2352x1568
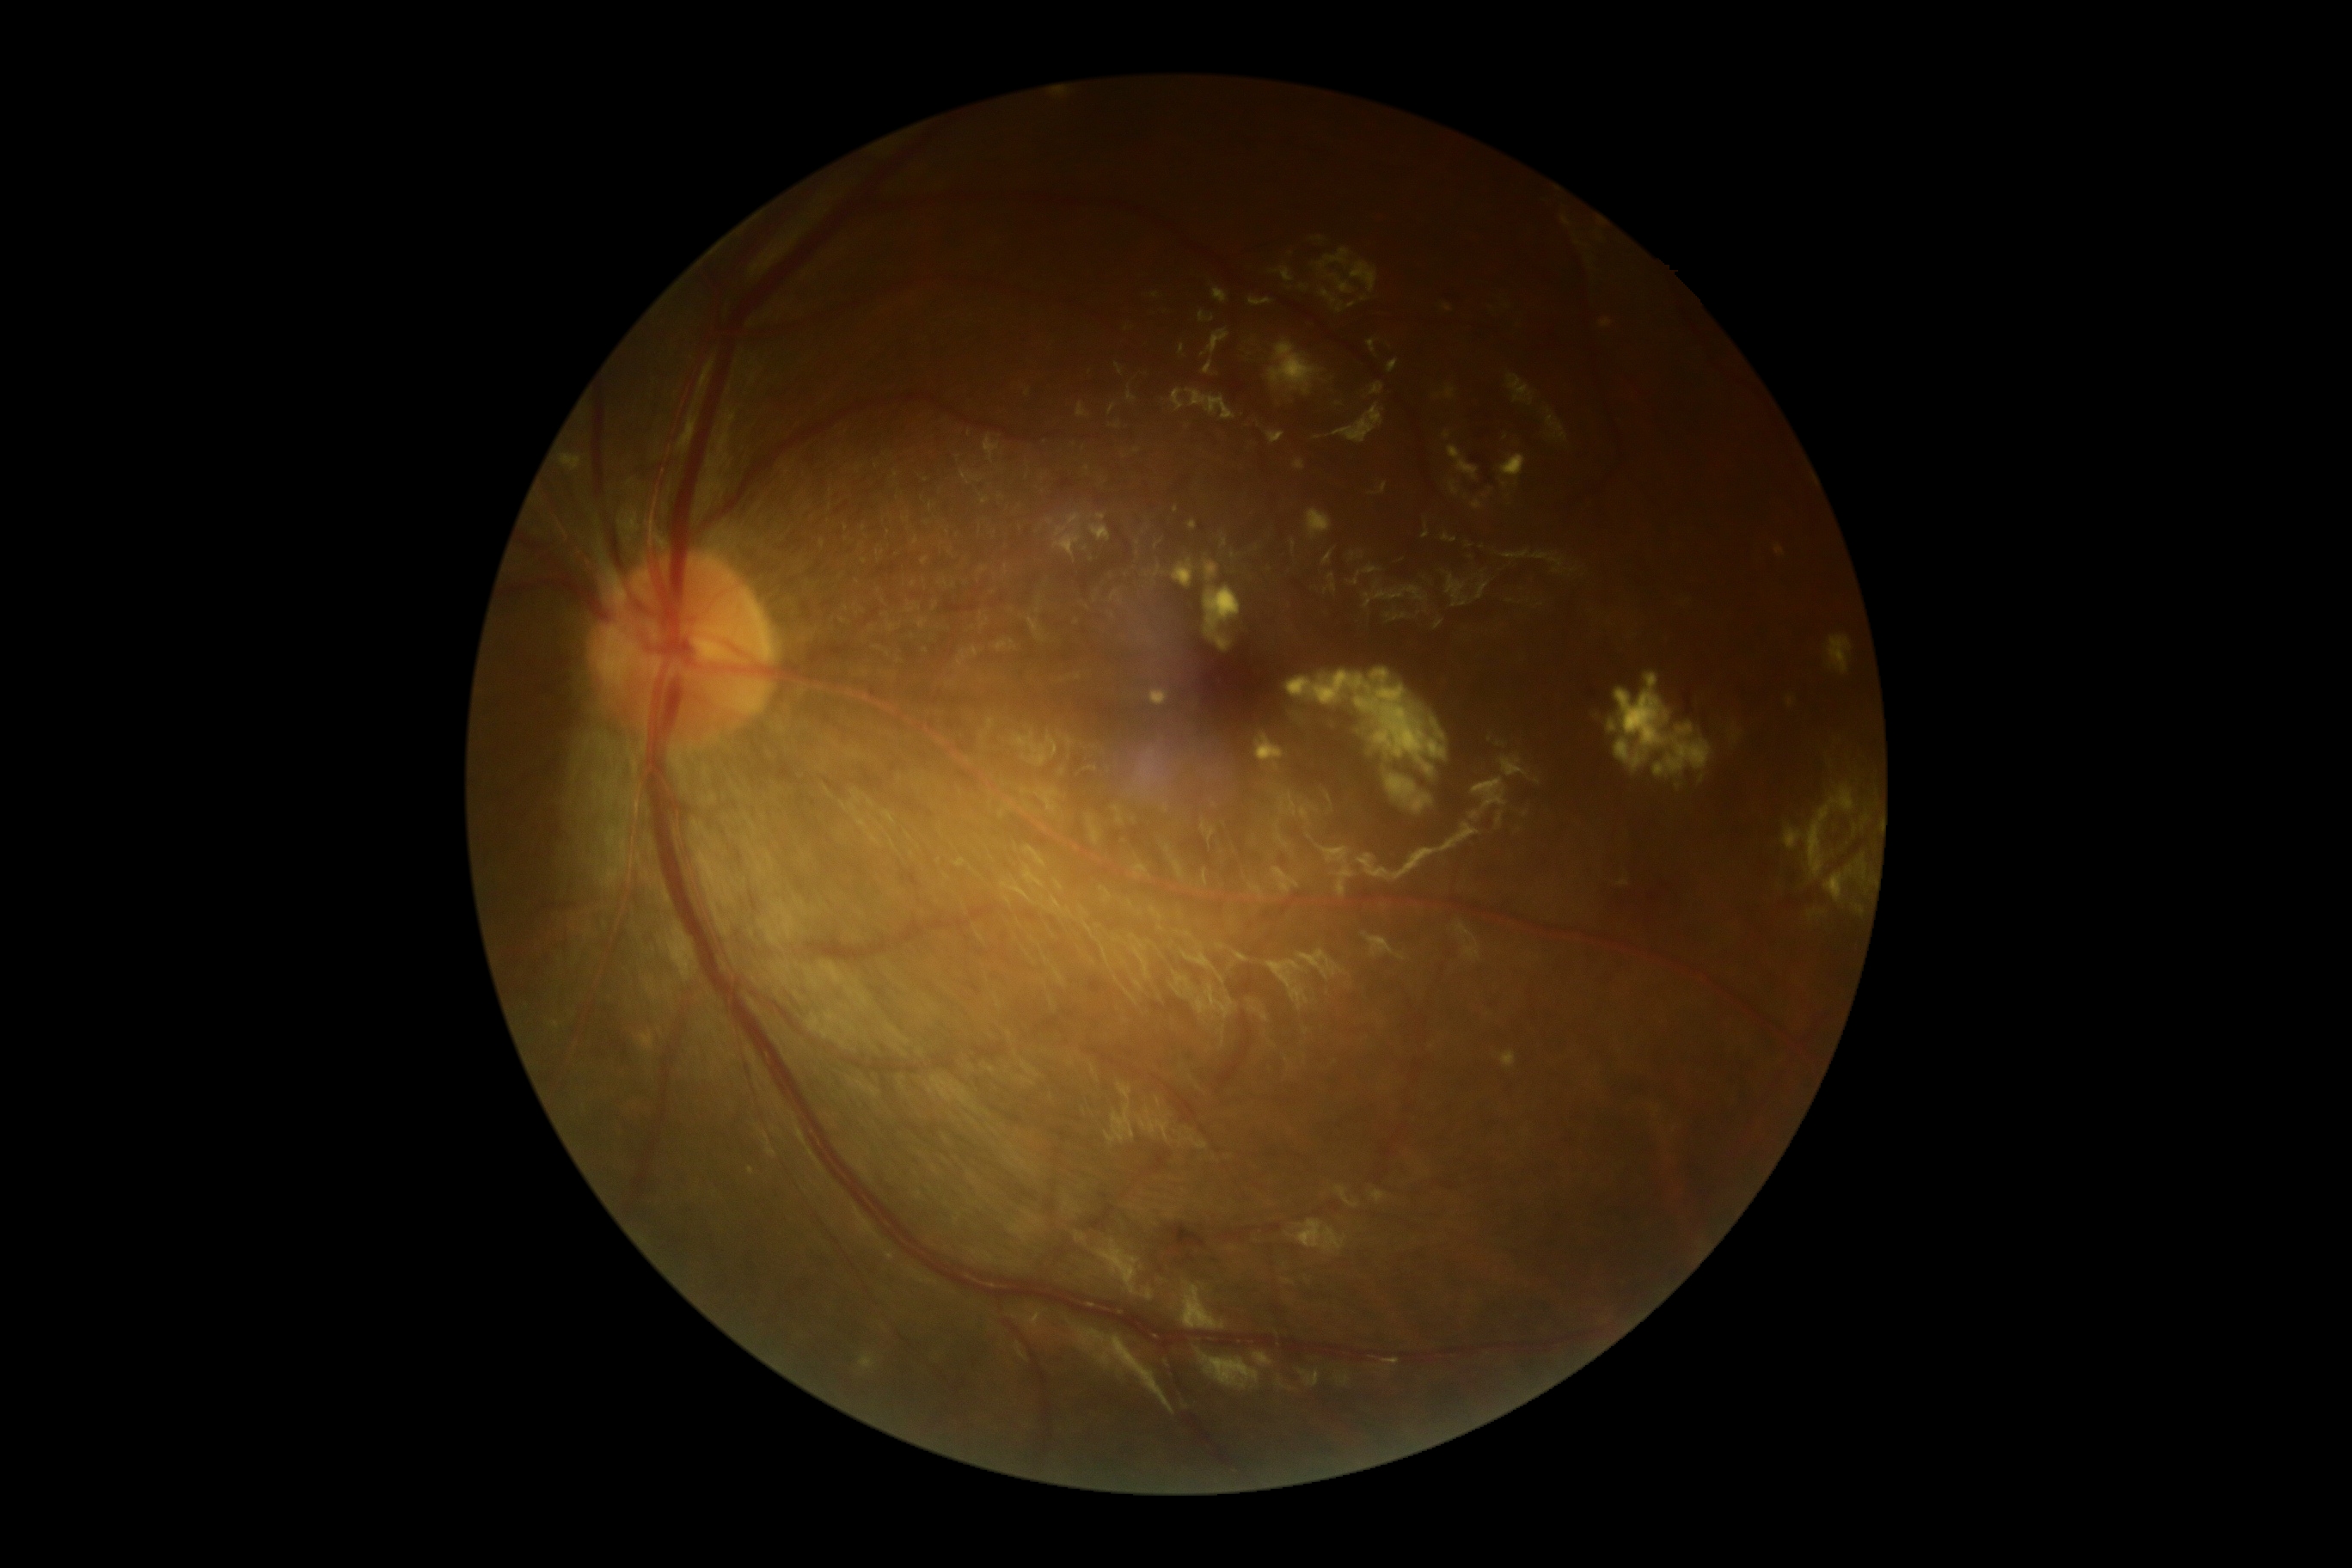

DR grade is 2.